Graded on the modified Davis scale
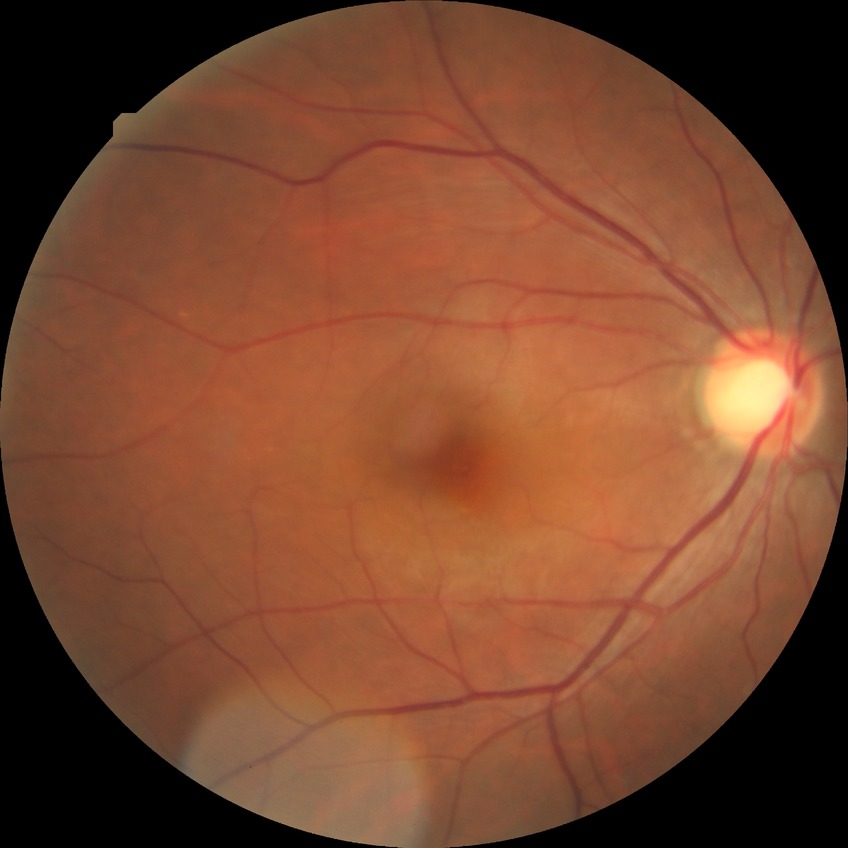
Findings:
– diabetic retinopathy (DR) — no diabetic retinopathy (NDR)